Fundus photo: 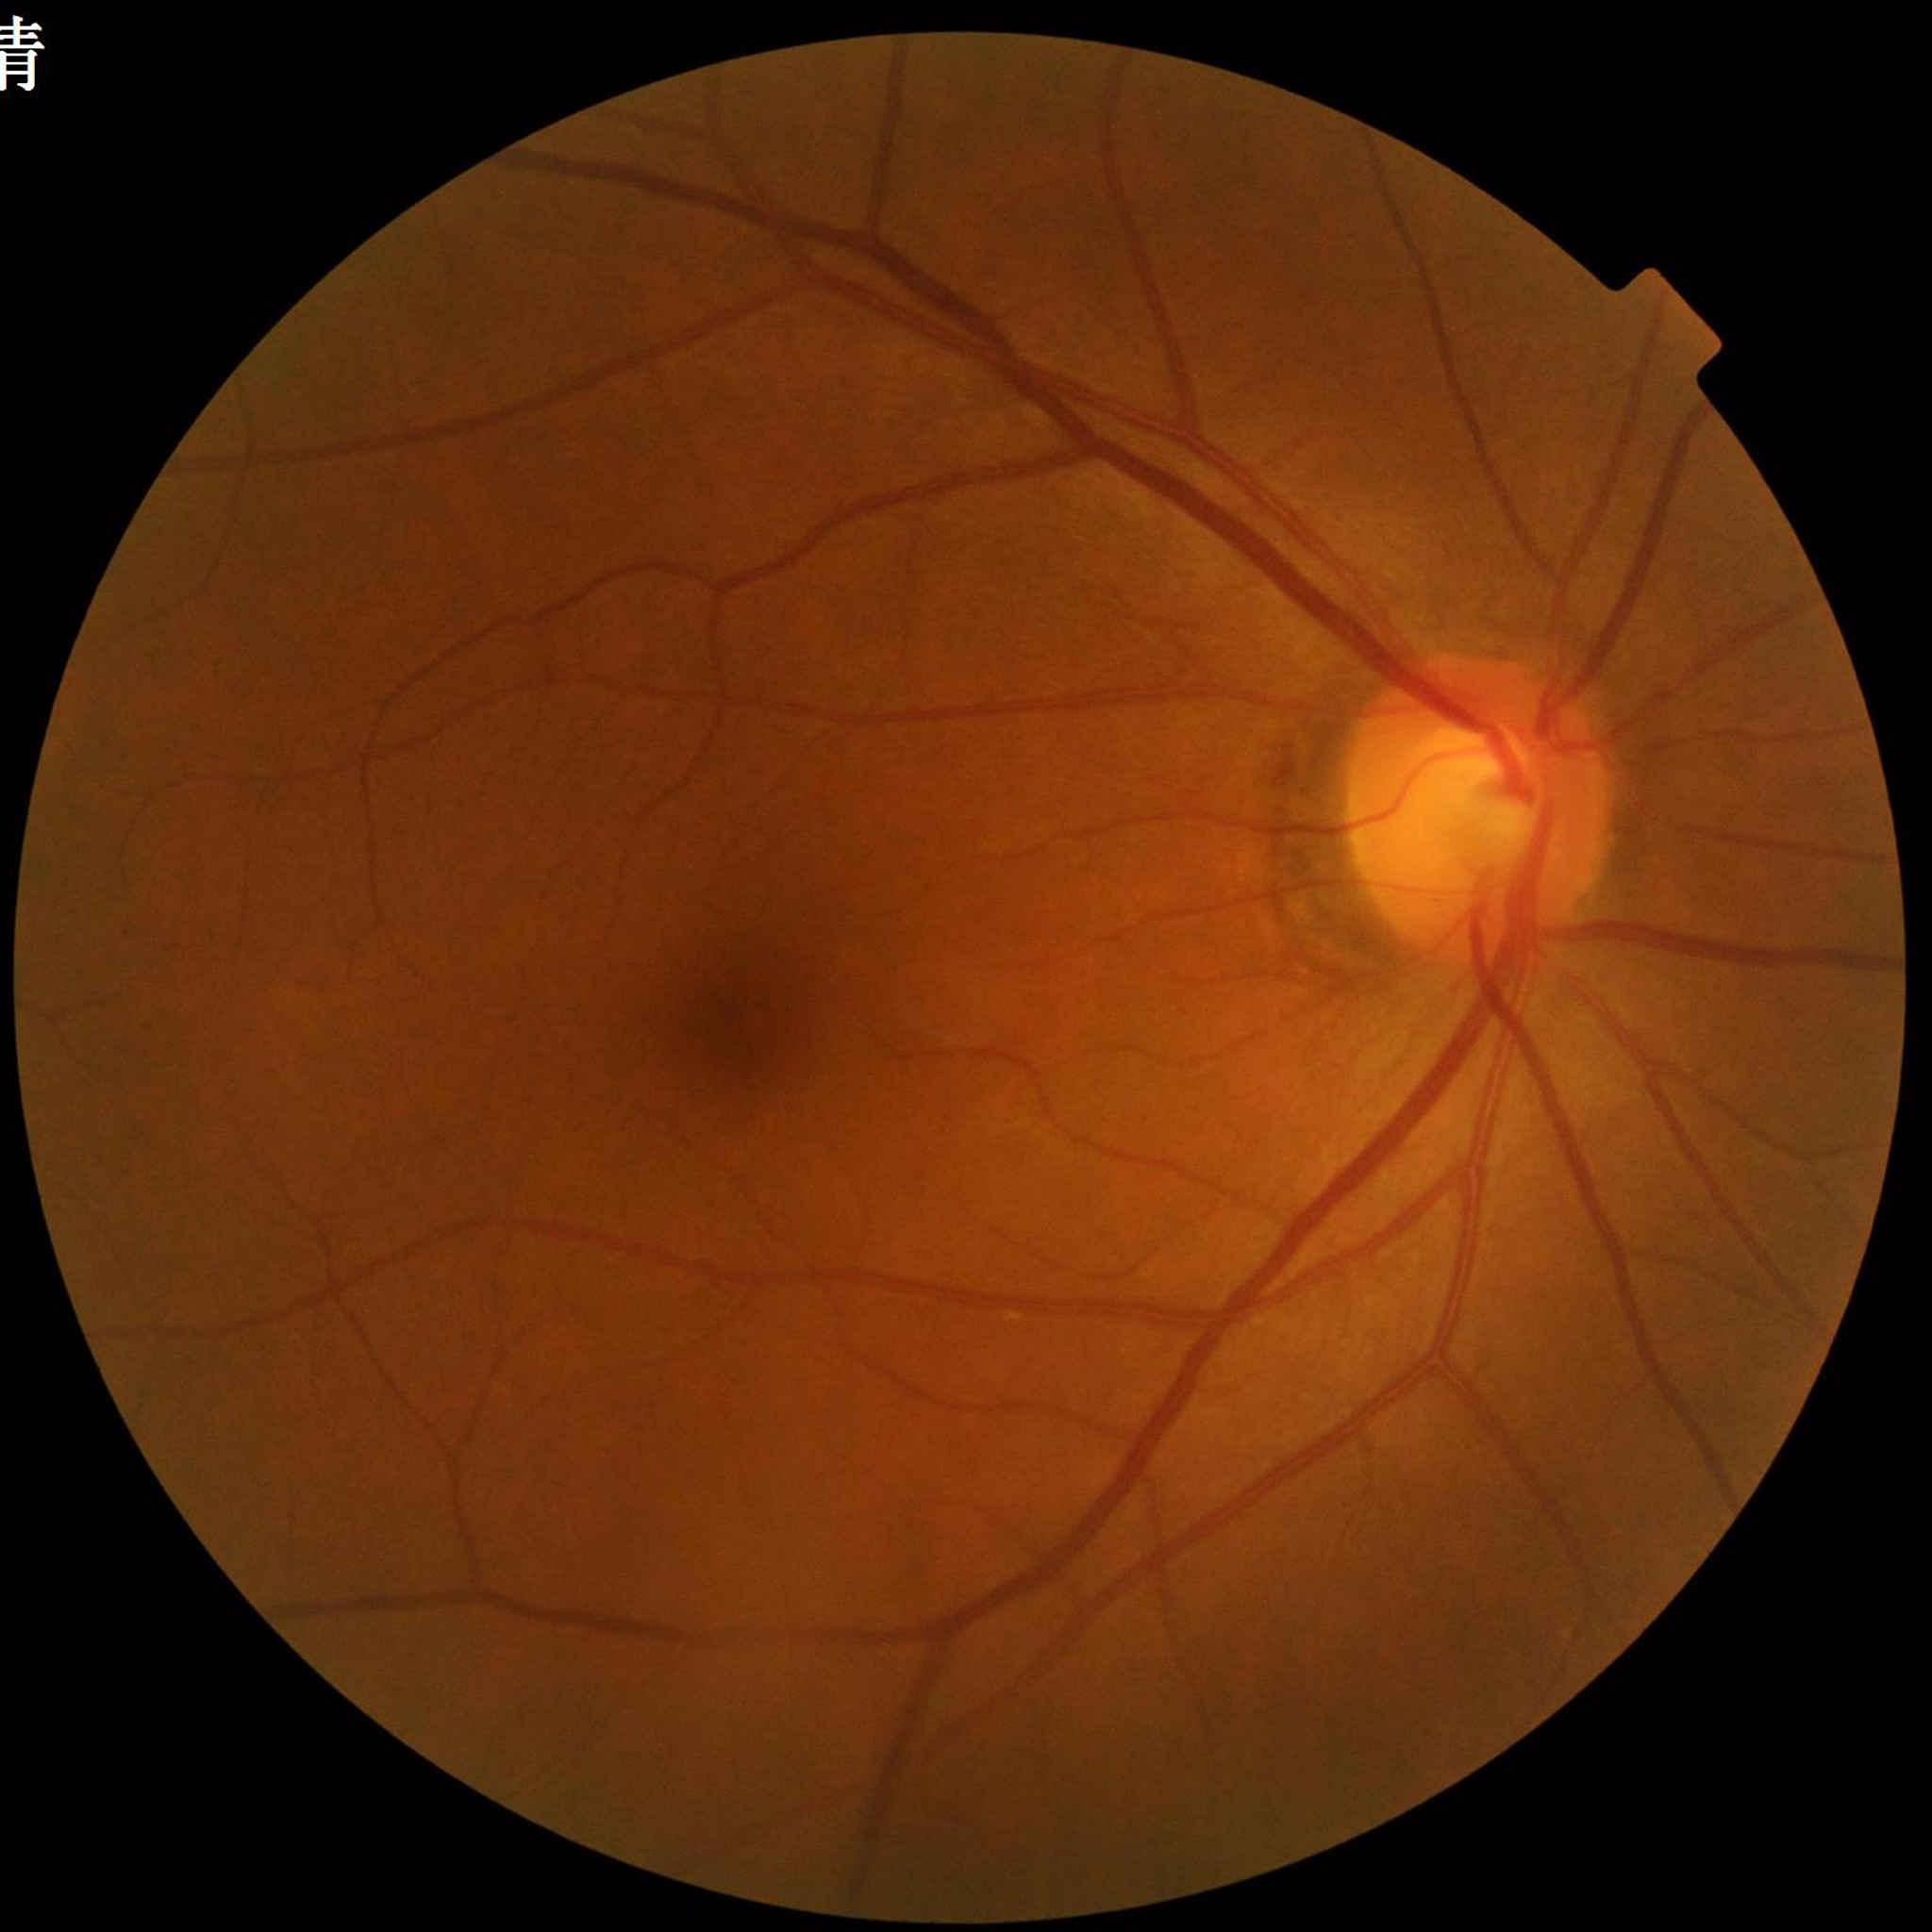
{
  "diagnosis": "diabetic retinopathy"
}